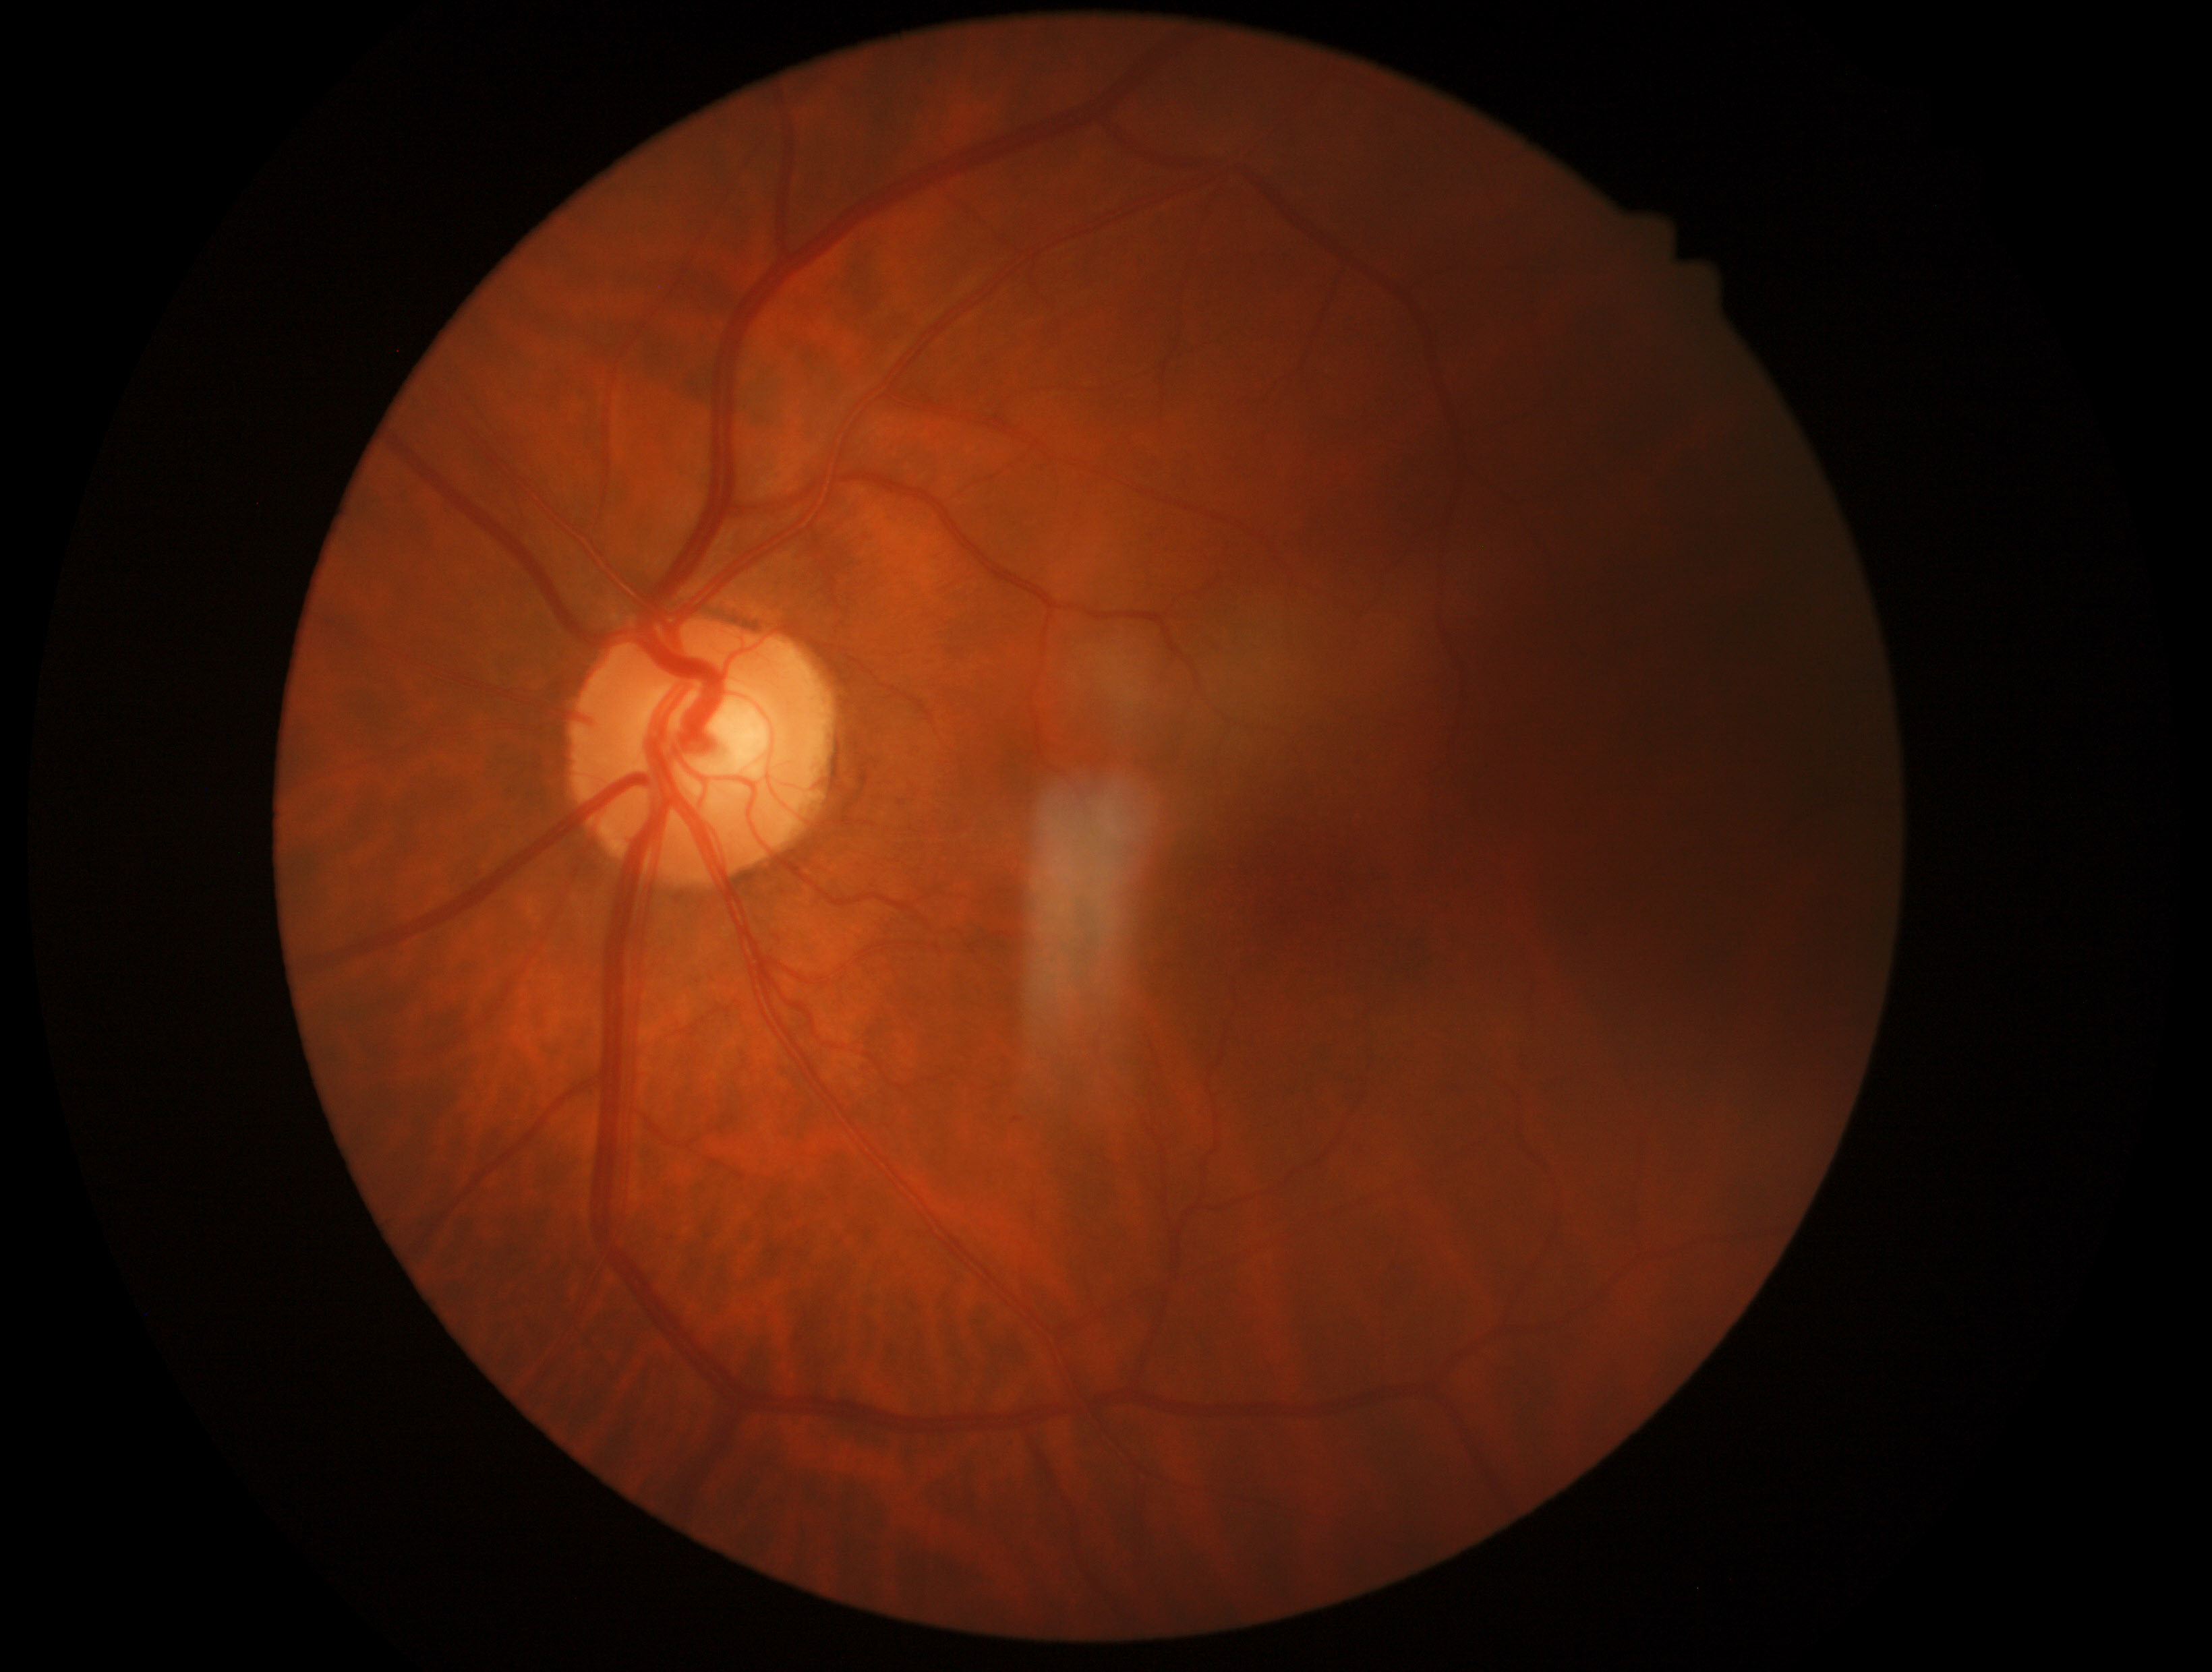
Diabetic retinopathy severity is 0/4.